848 x 848 pixels. 45° field of view. Camera: NIDEK AFC-230. Without pupil dilation. Color fundus image:
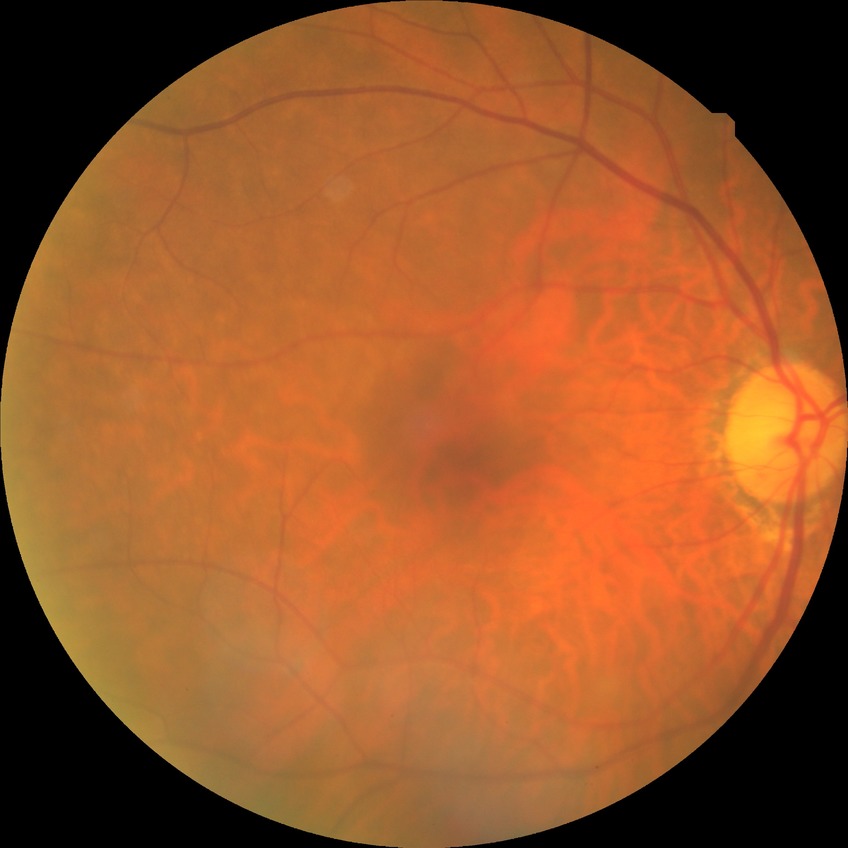
davis_grade: no diabetic retinopathy